Image size 2048x1536; 45° FOV
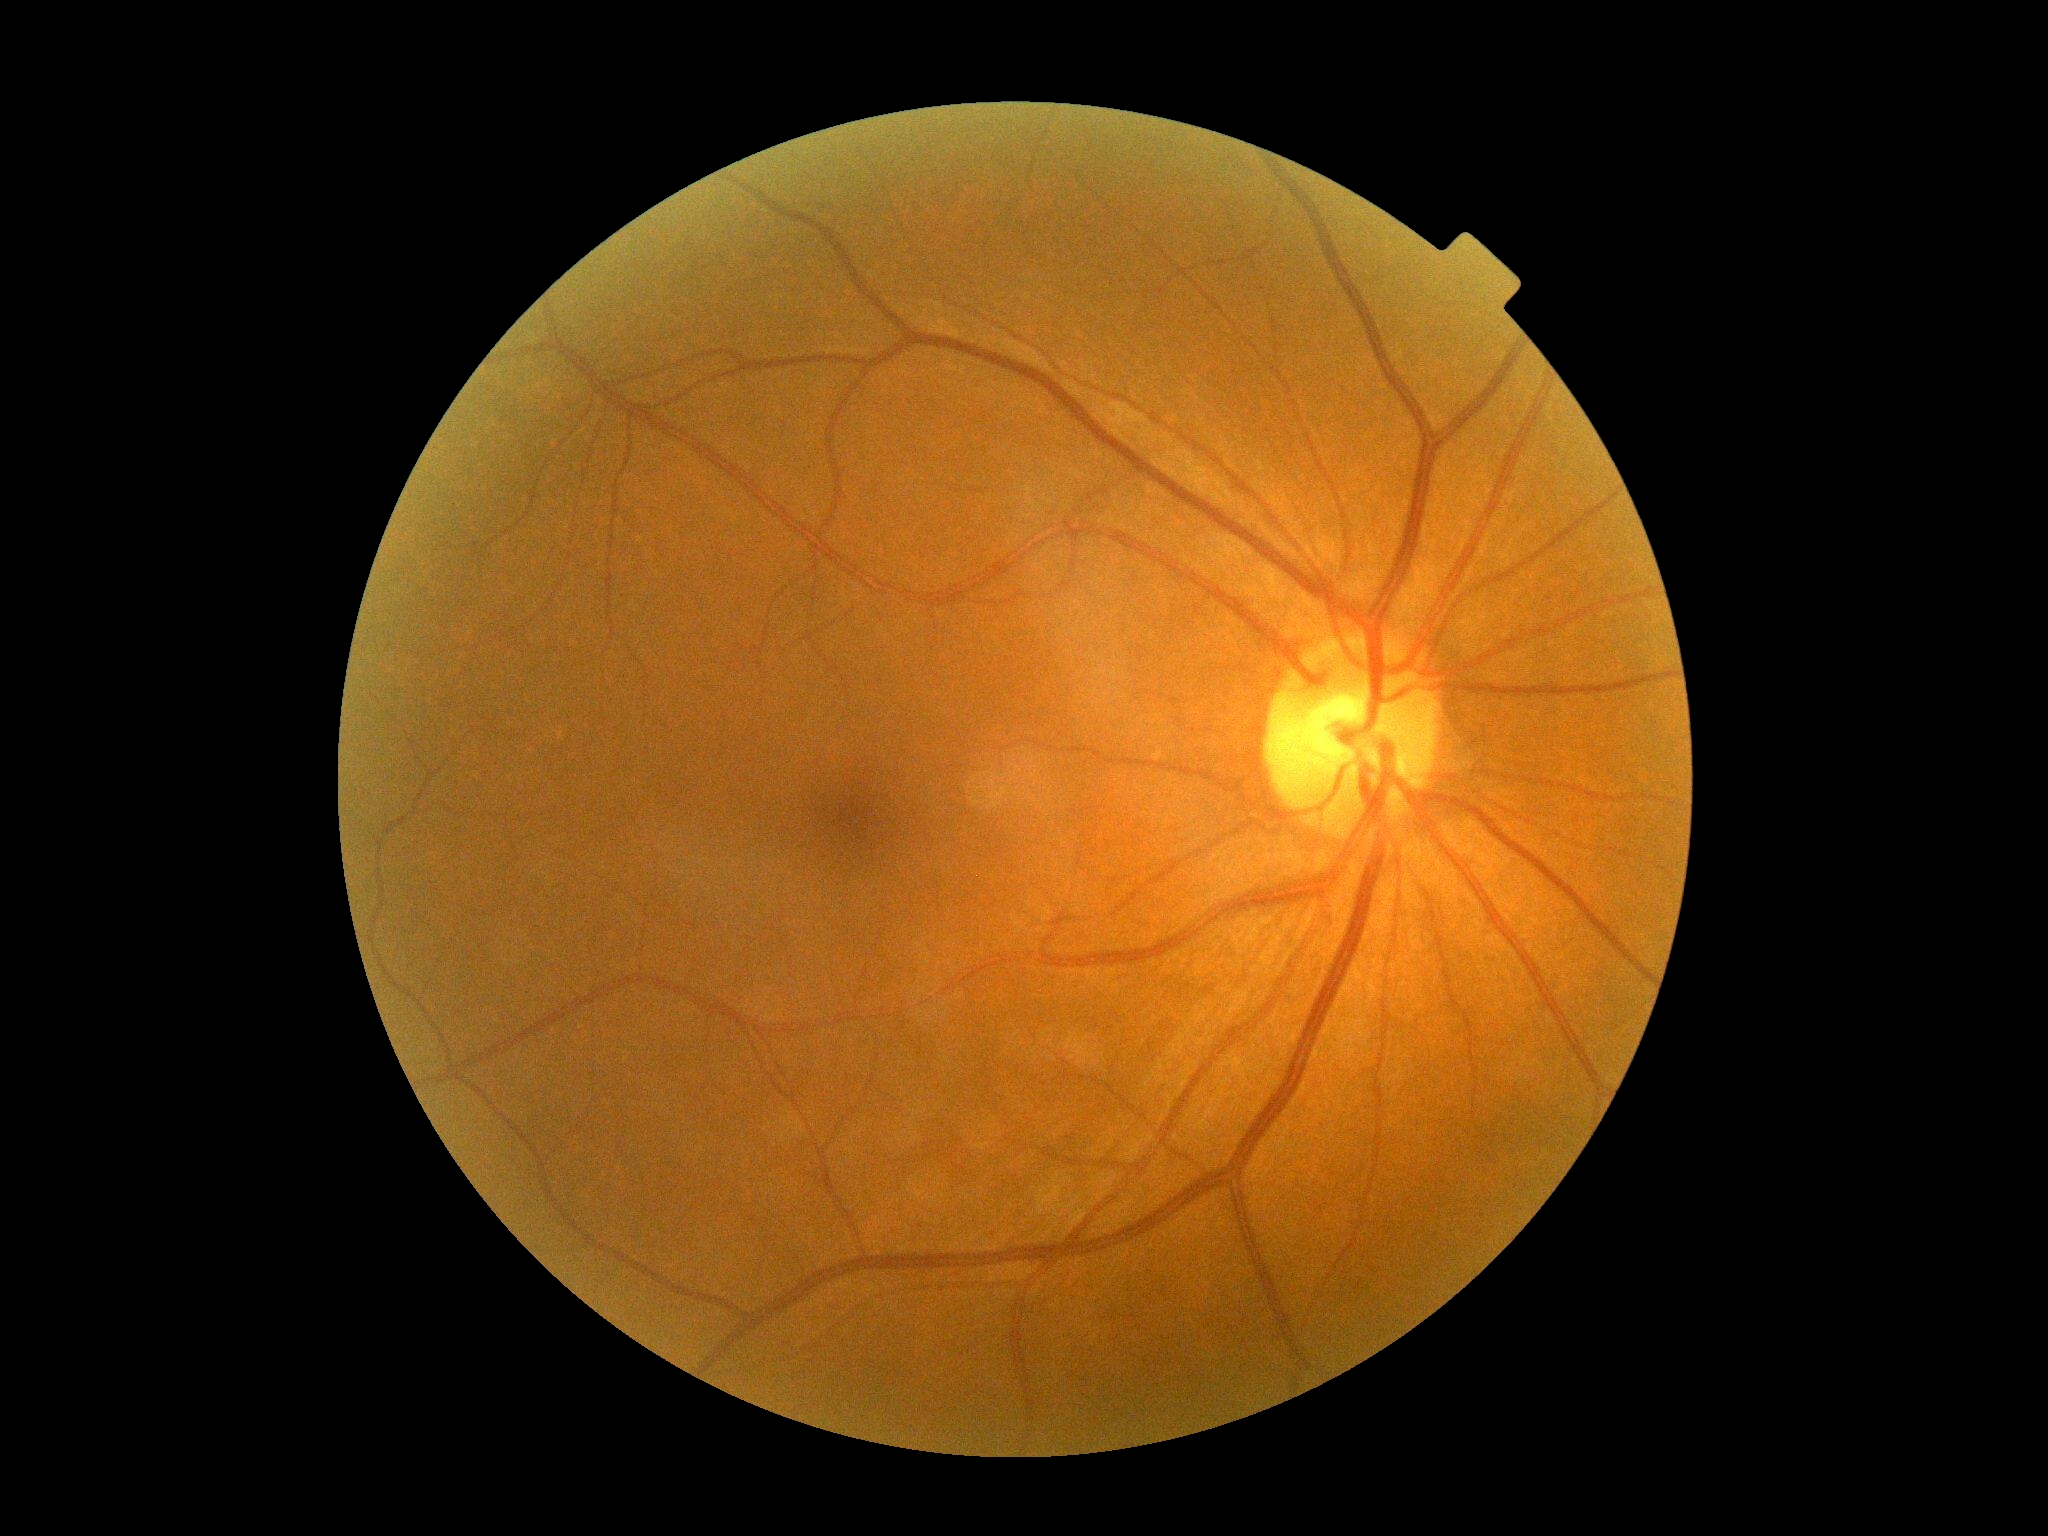

{"dr_grade": "no apparent retinopathy (0)", "dr_impression": "no signs of DR"}